2089x1764, retinal fundus photograph: 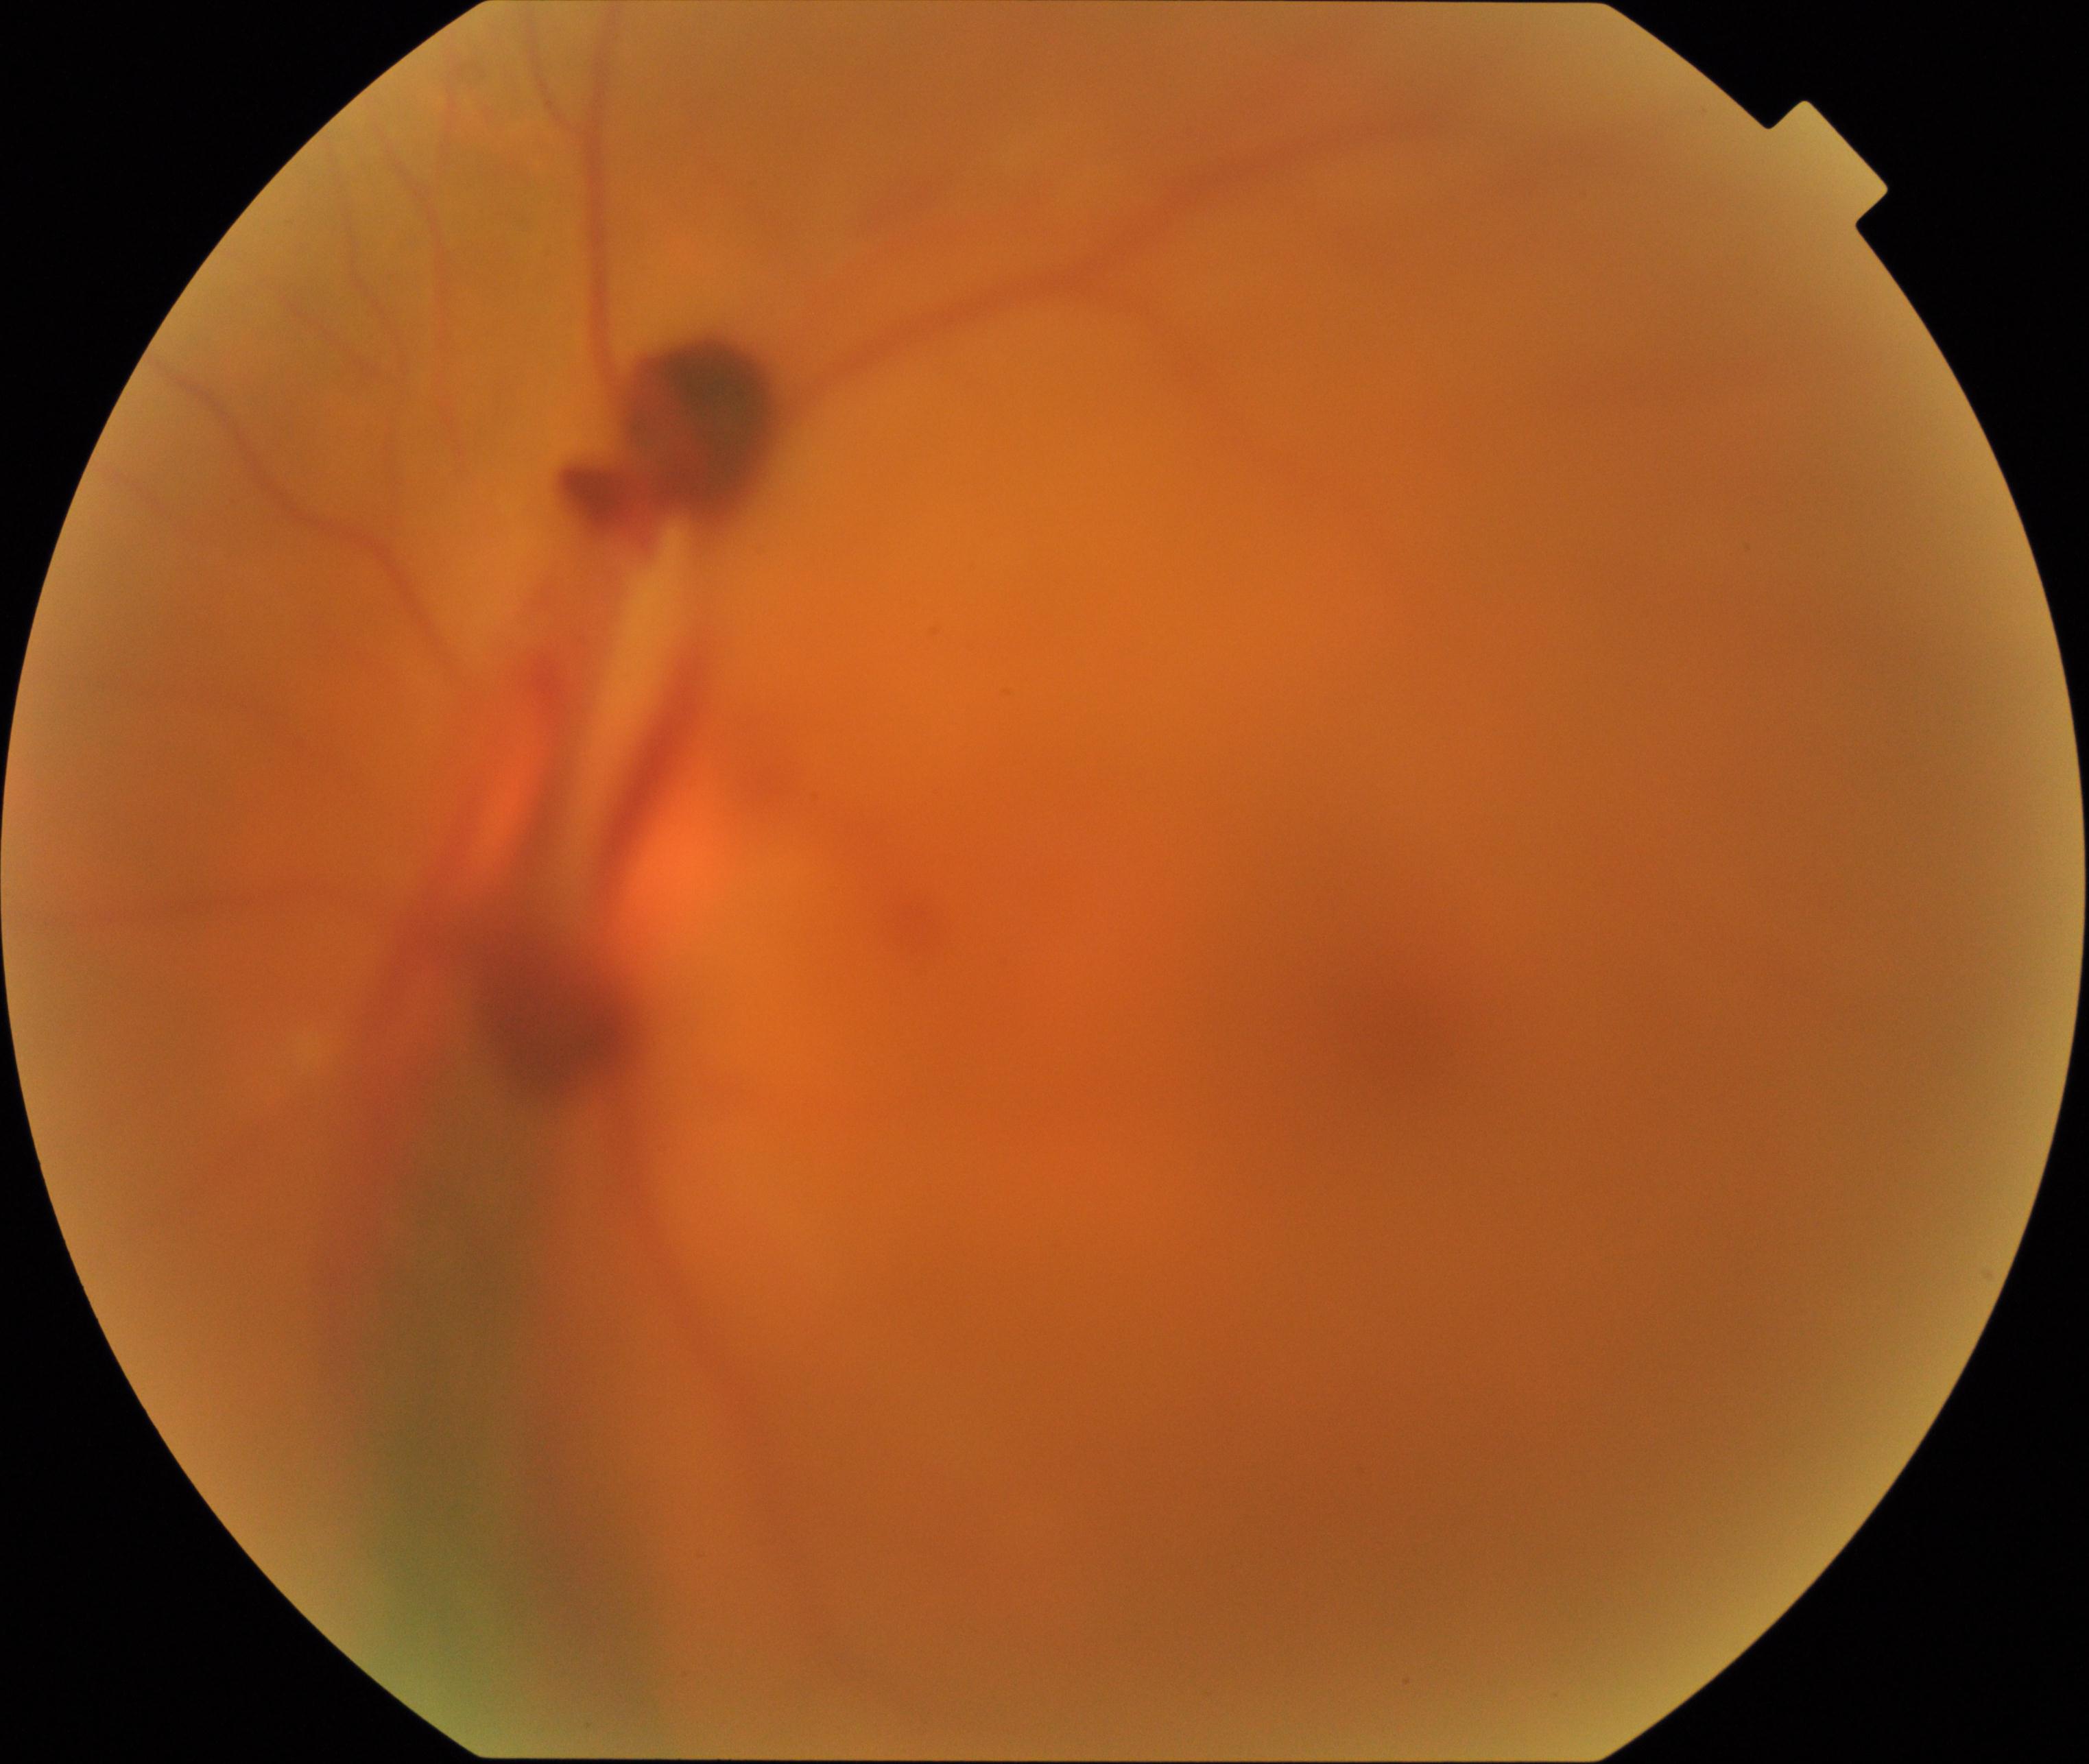
Gradability: significantly degraded. Proliferative retinopathy: suspected, not confirmed.